Captured with the Natus RetCam Envision (130° field of view). Wide-field fundus image from infant ROP screening: 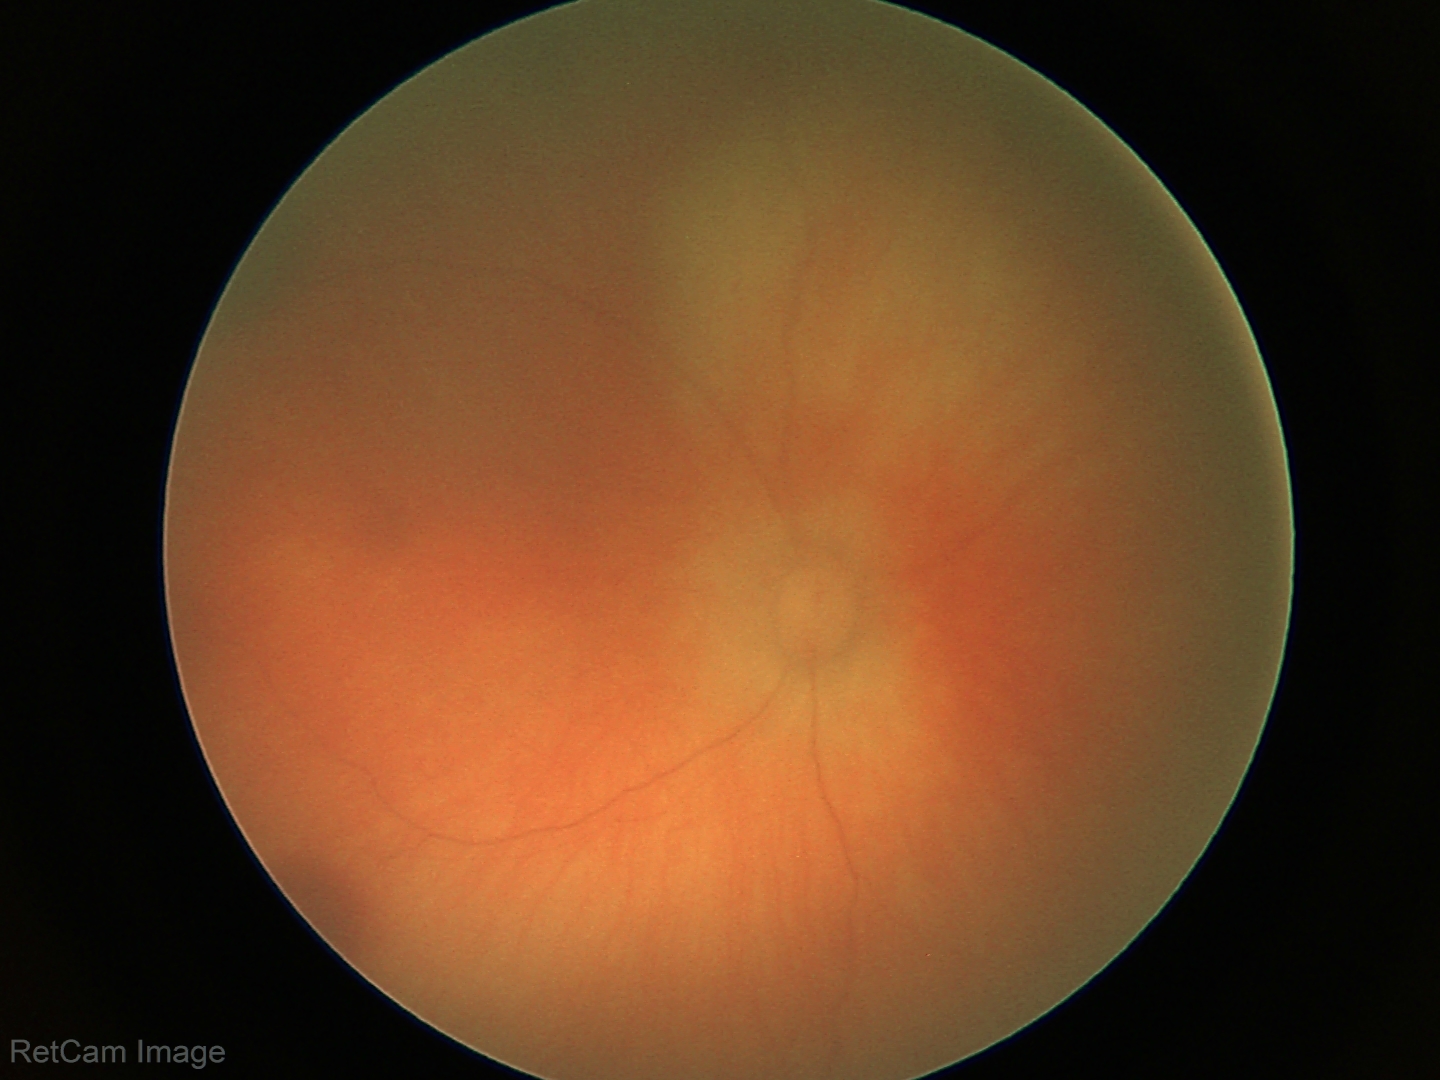

Screening diagnosis = retinal hemorrhages.